Without pupil dilation. CFP — 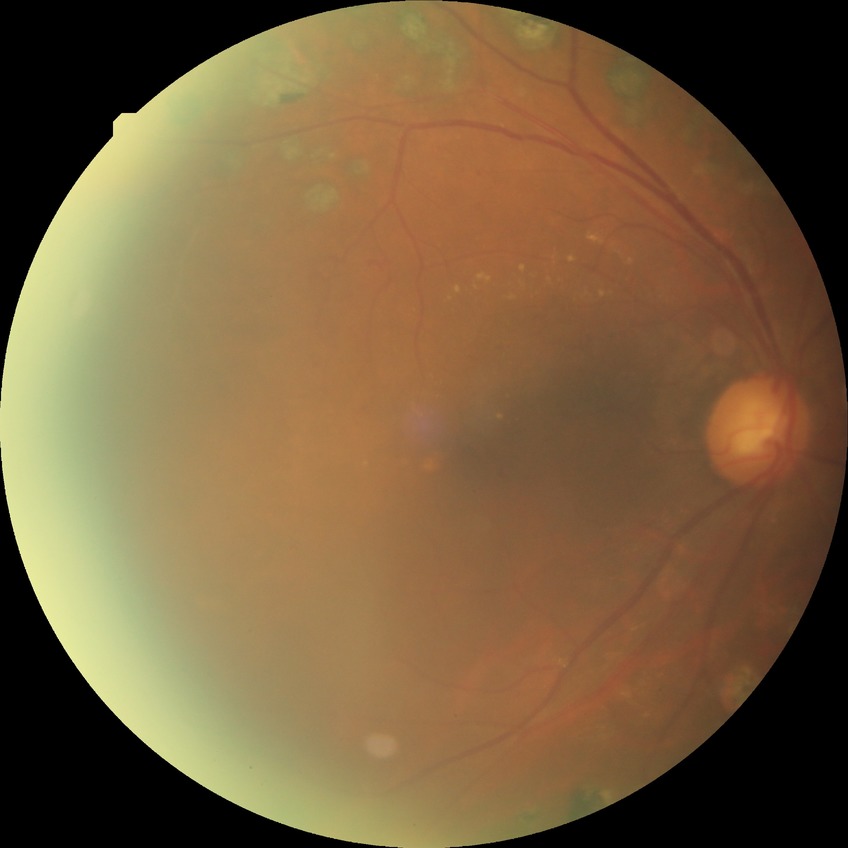

Retinopathy grade: proliferative diabetic retinopathy.